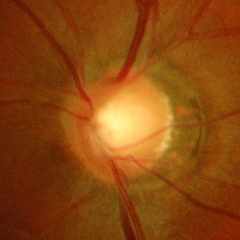

Optic disc photograph demonstrating advanced glaucoma.